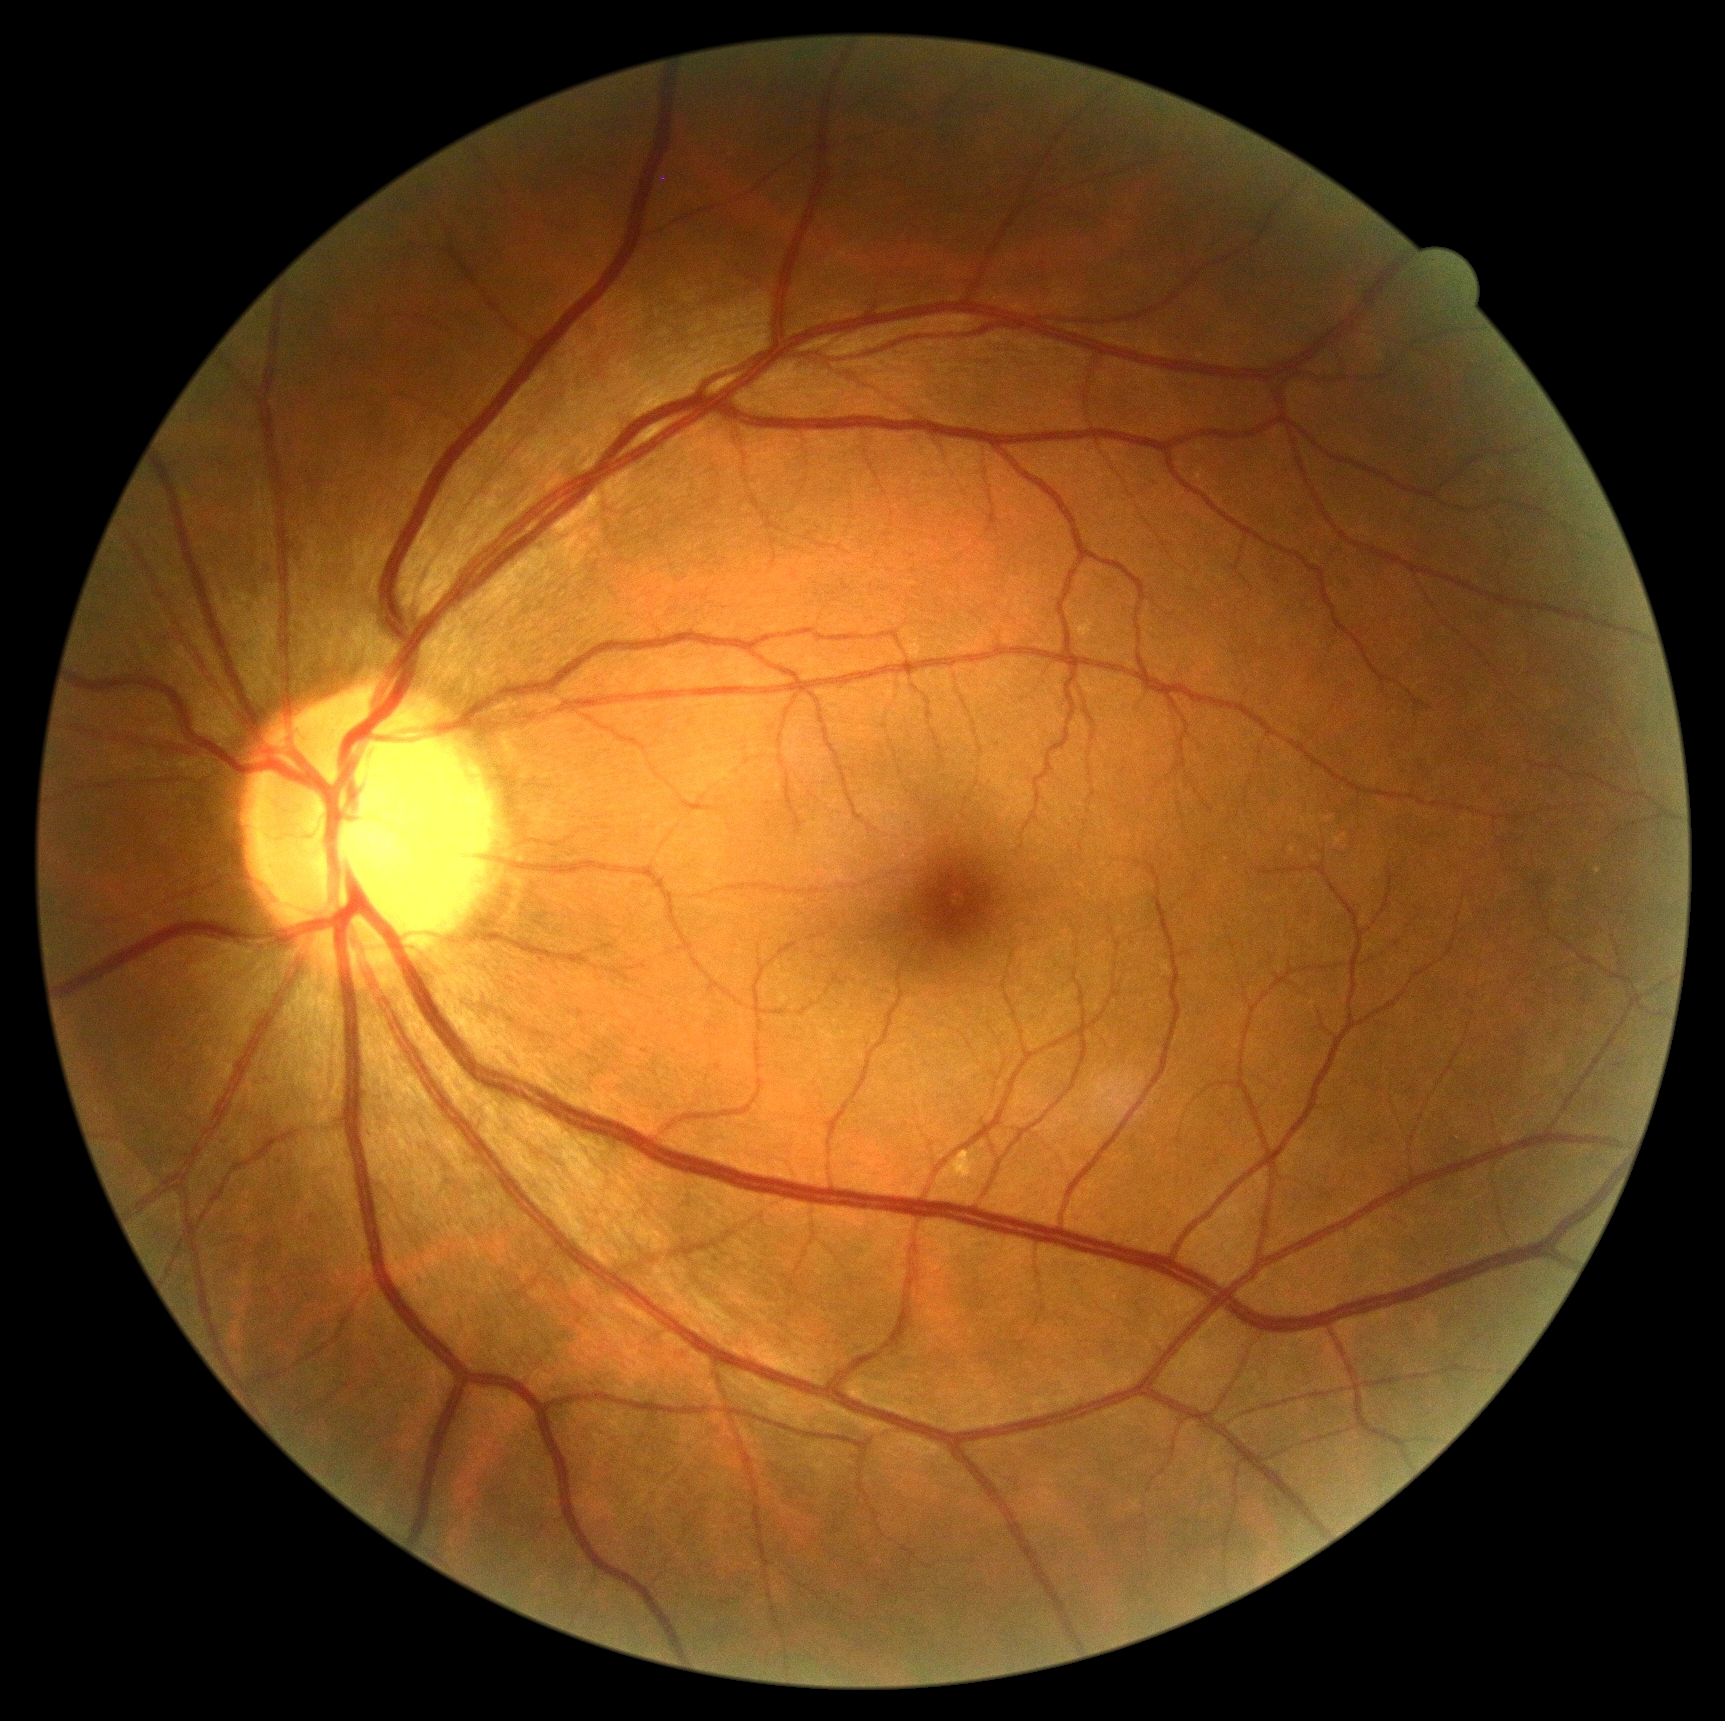 retinopathy grade = 0 (no apparent retinopathy)